Image size 848x848; nonmydriatic; retinal fundus photograph; acquired with a NIDEK AFC-230
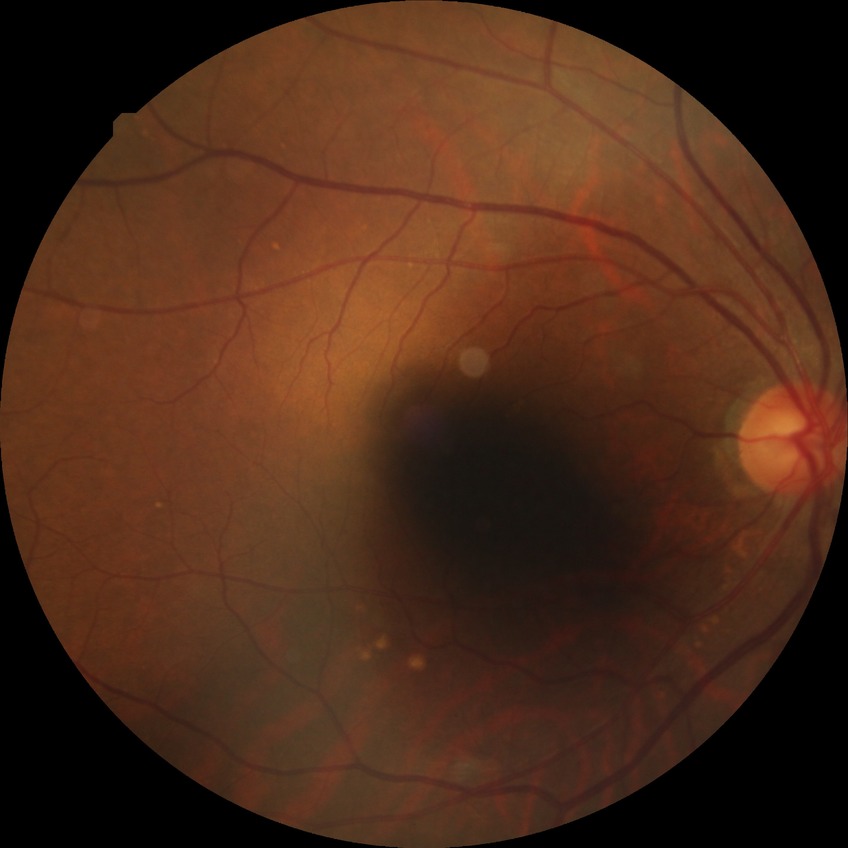

{
  "davis_grade": "simple diabetic retinopathy"
}